Color fundus image — 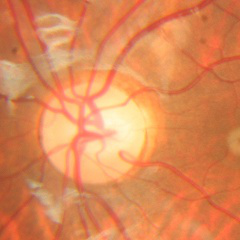
The image shows no glaucomatous optic neuropathy.